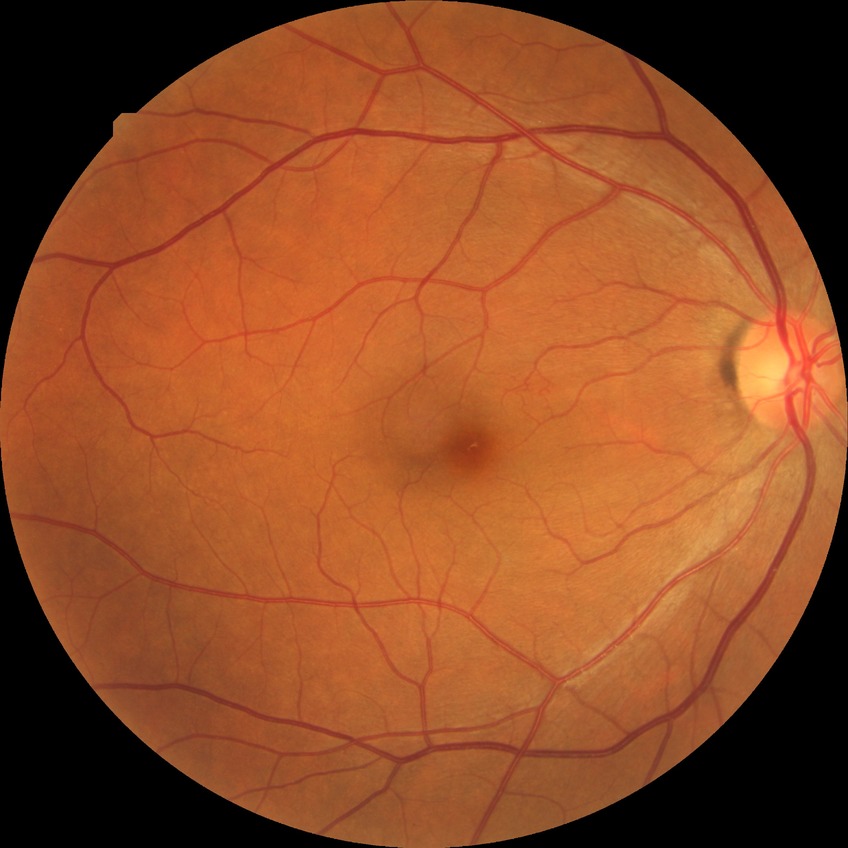

Diabetic retinopathy severity is no diabetic retinopathy.